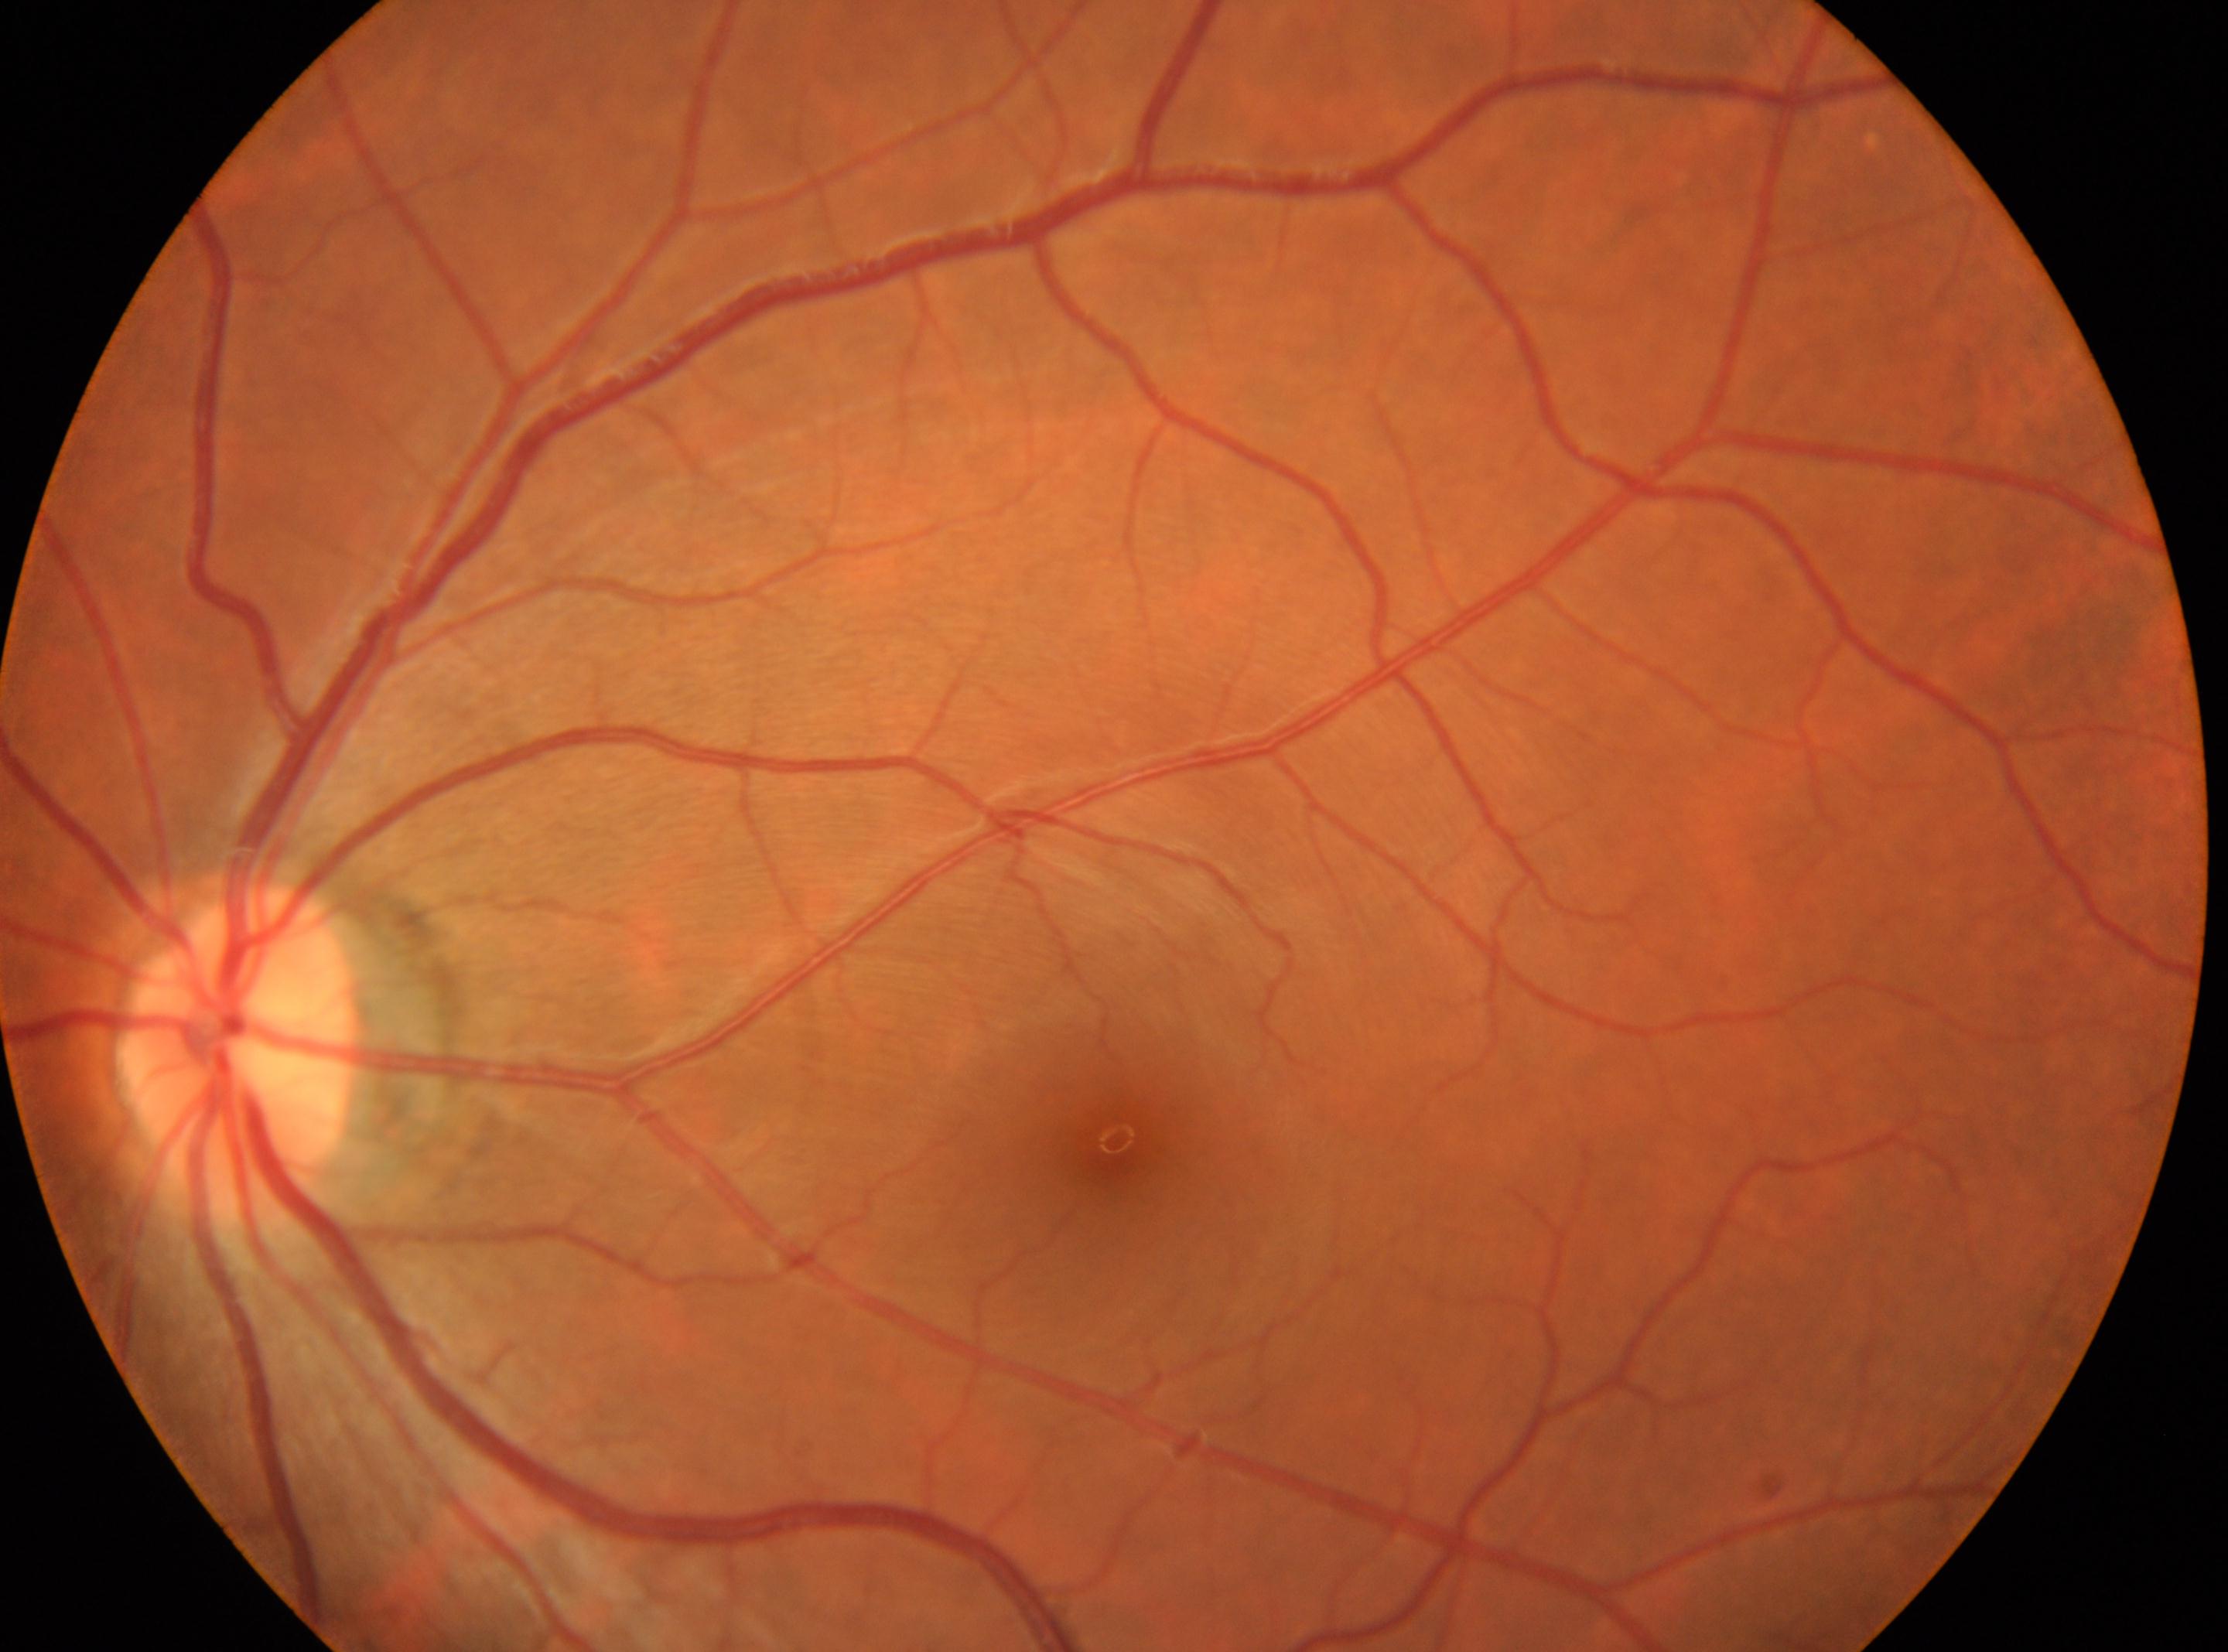

macular center = (1116, 1140); DR stage = 0/4 — no visible signs of diabetic retinopathy; eye = OS; optic disc = (238, 1044).